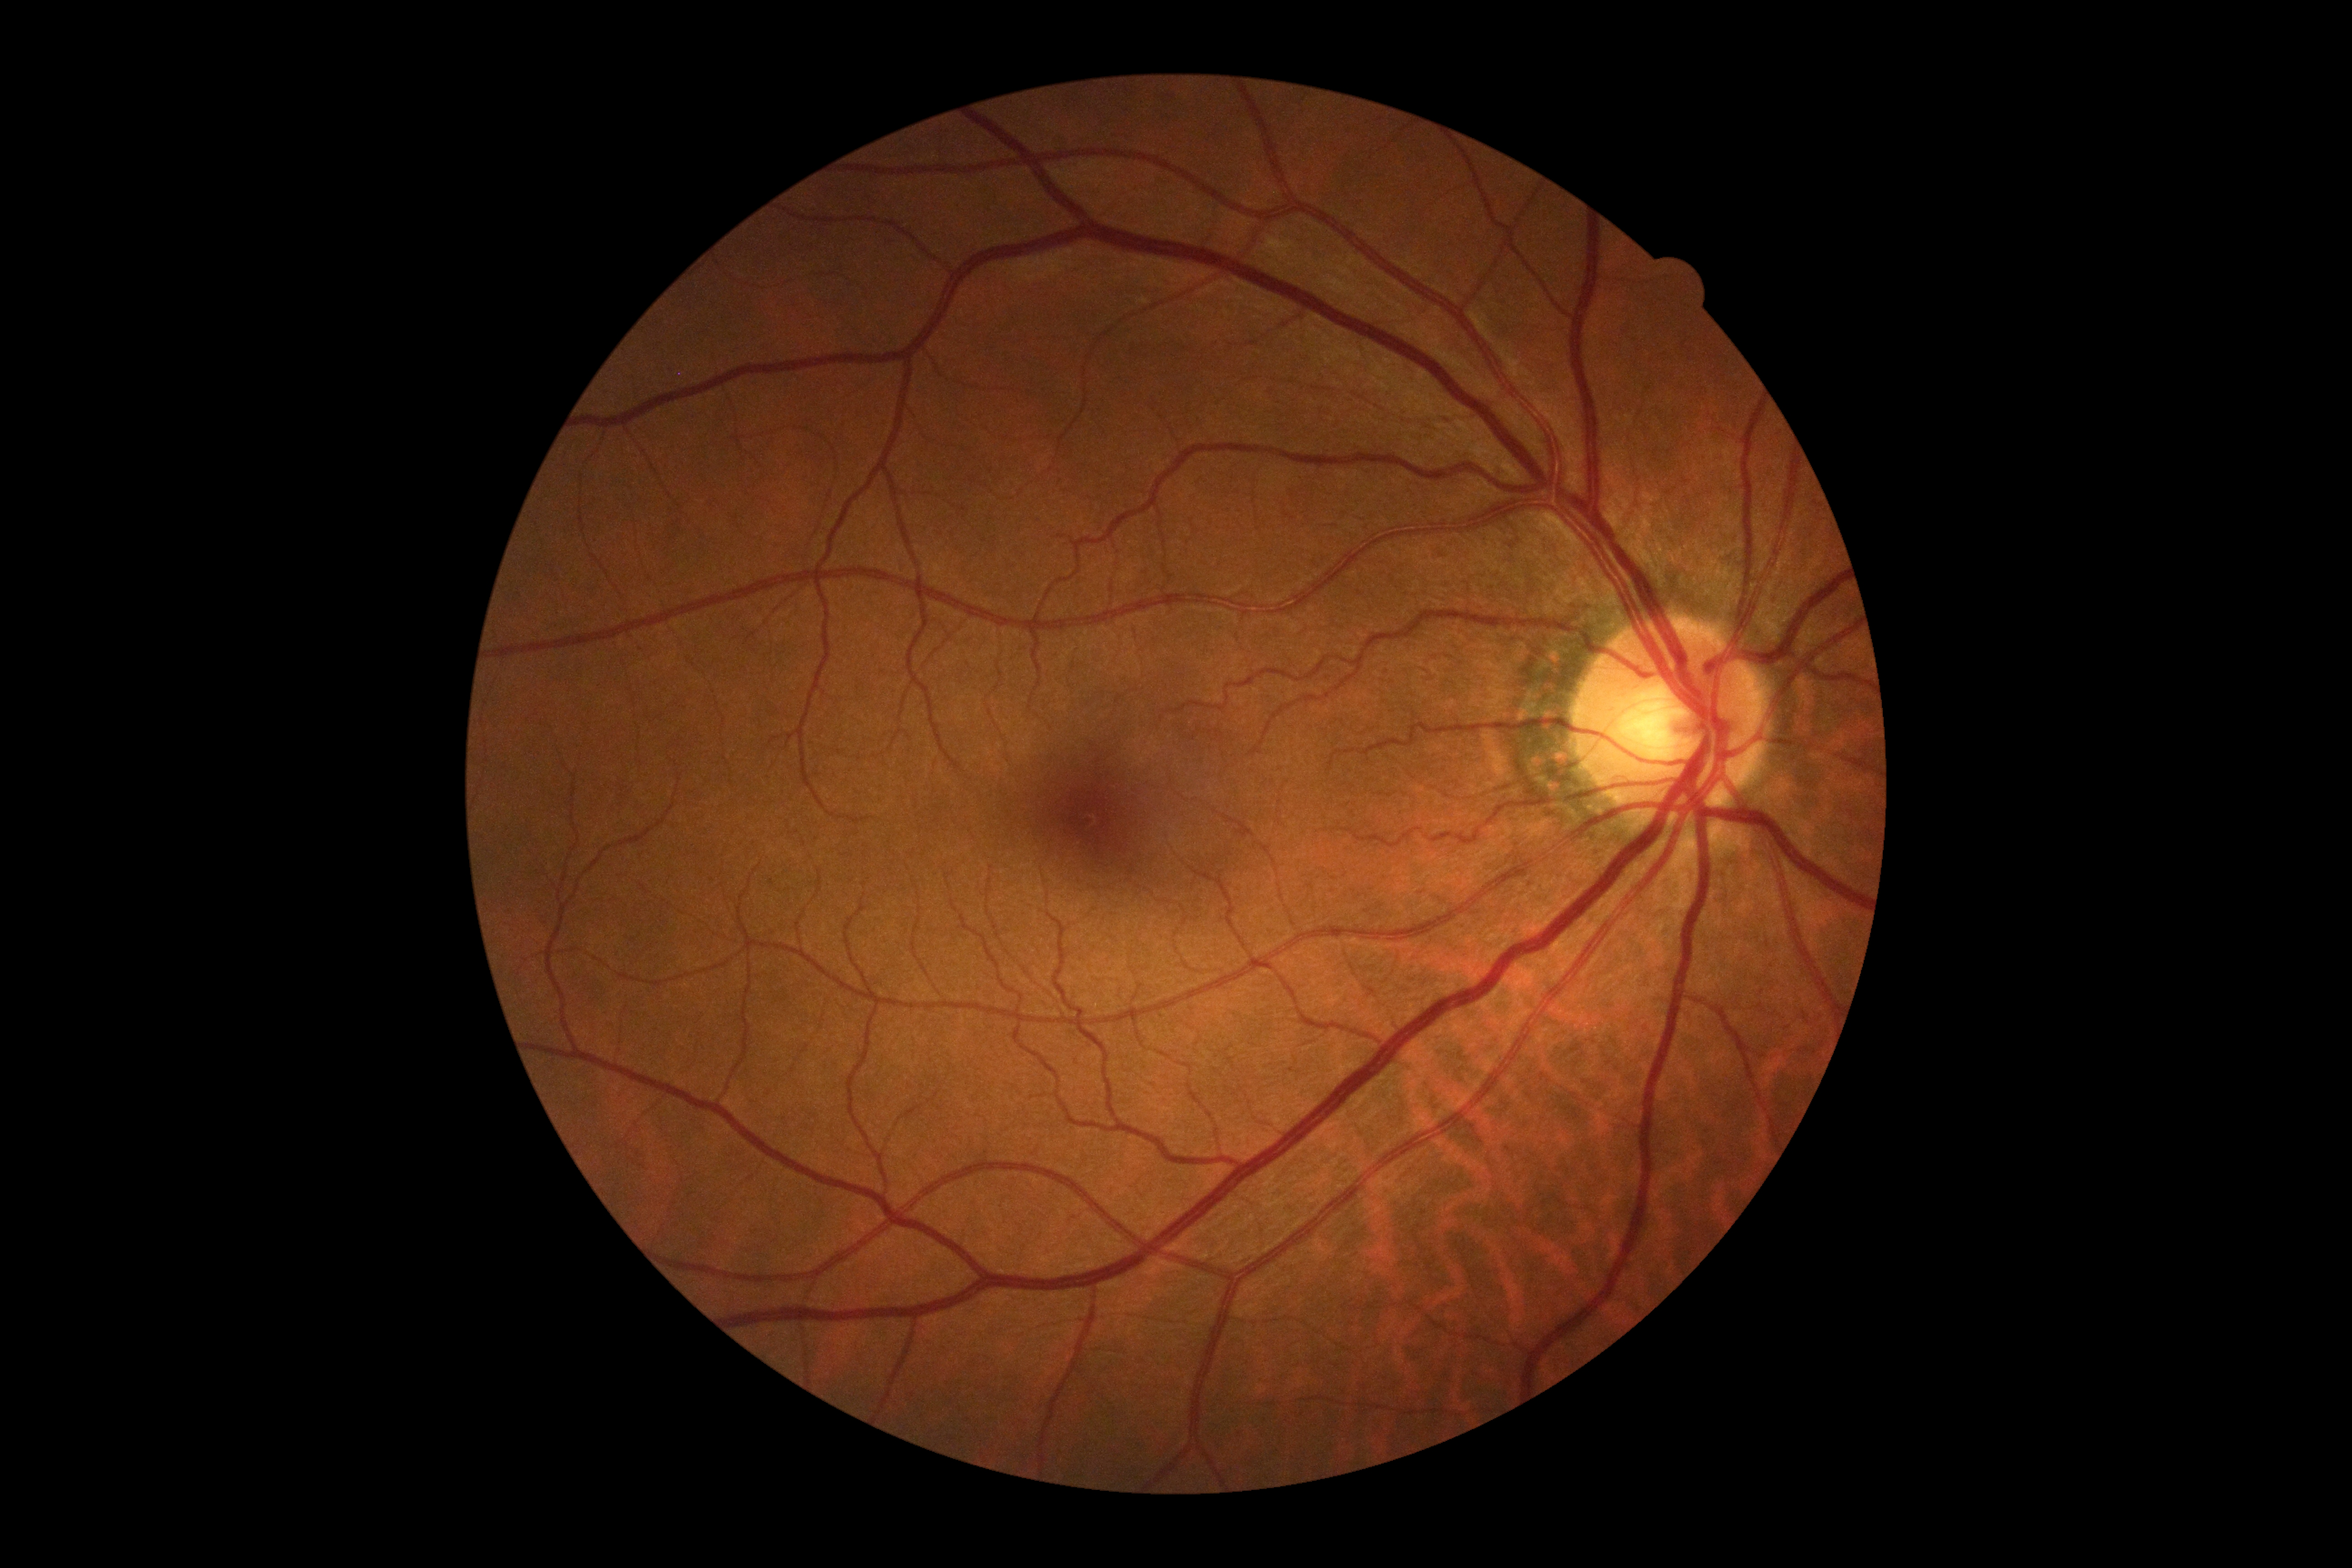 Diabetic retinopathy (DR) is no apparent retinopathy (grade 0).